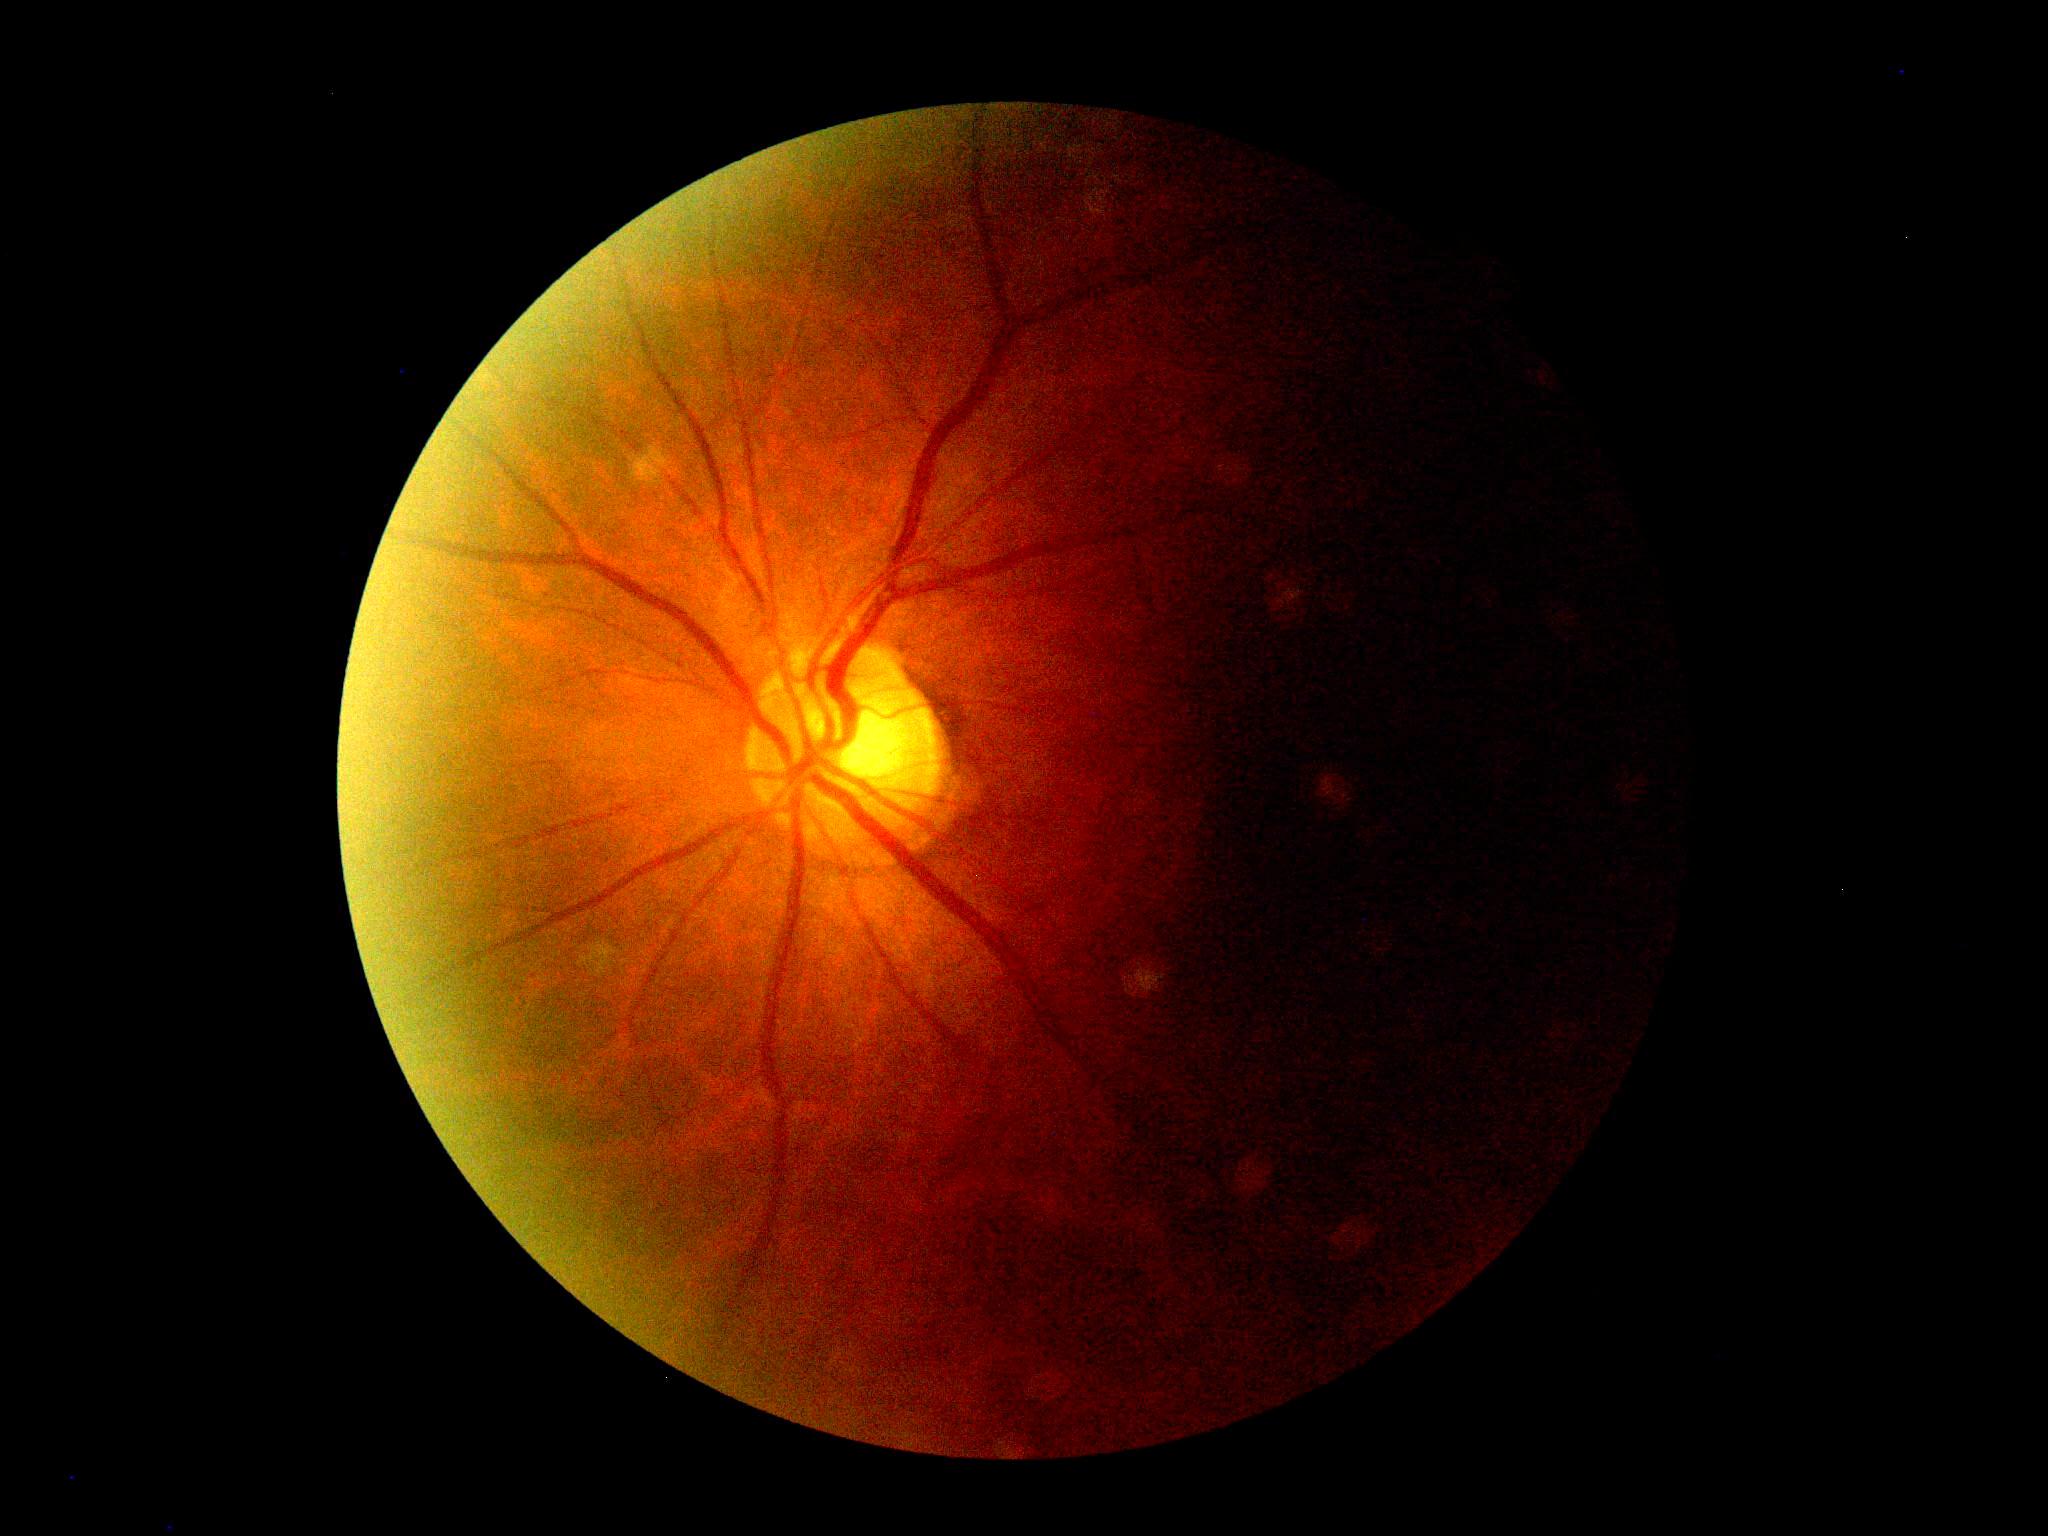 DR stage: ungradable.